848 x 848 pixels. Fundus photo. FOV: 45 degrees. Modified Davis grading. Camera: NIDEK AFC-230
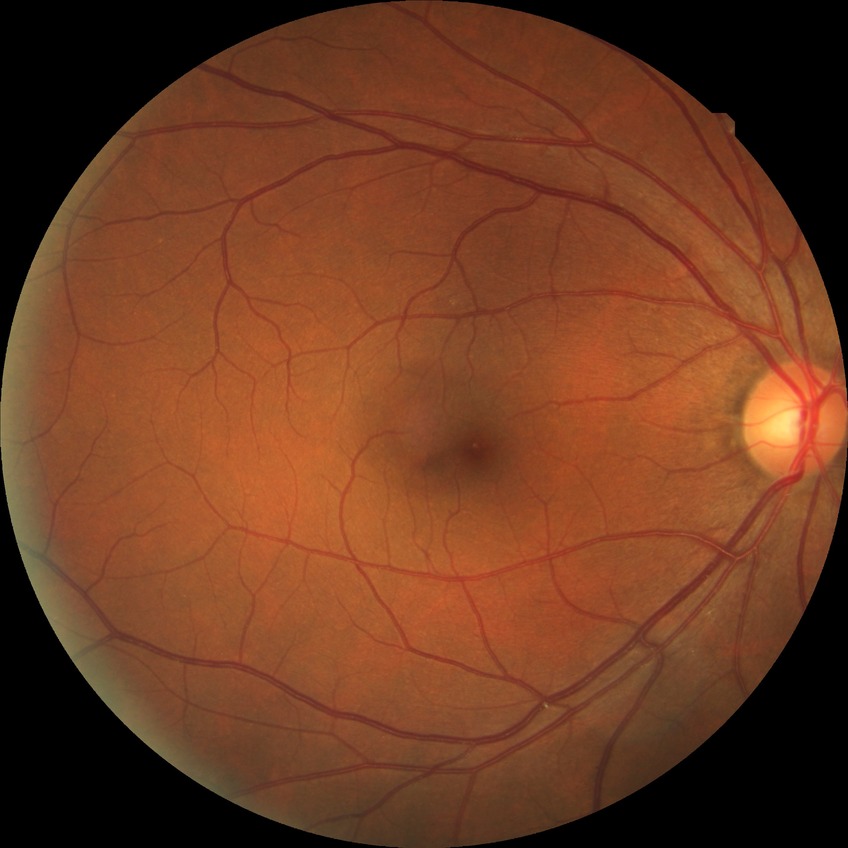

diabetic retinopathy severity: no diabetic retinopathy.